Pediatric retinal photograph (wide-field) · 1440 x 1080 pixels:
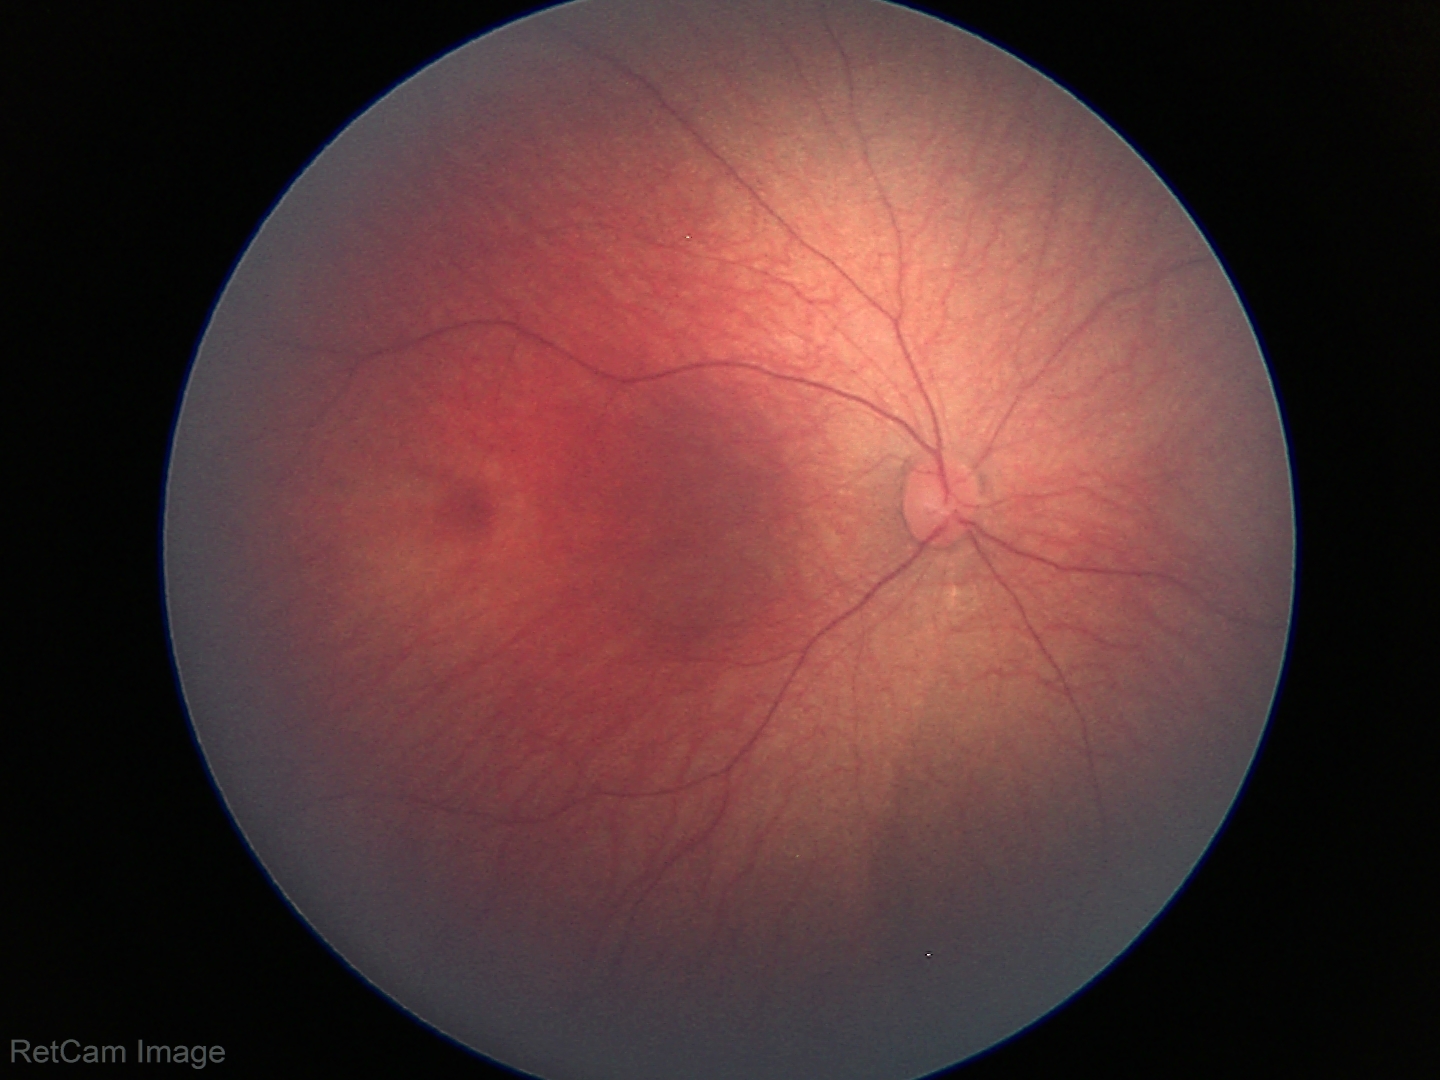
Diagnosis: no abnormalities.